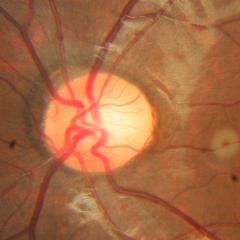 Impression = no glaucomatous changes.